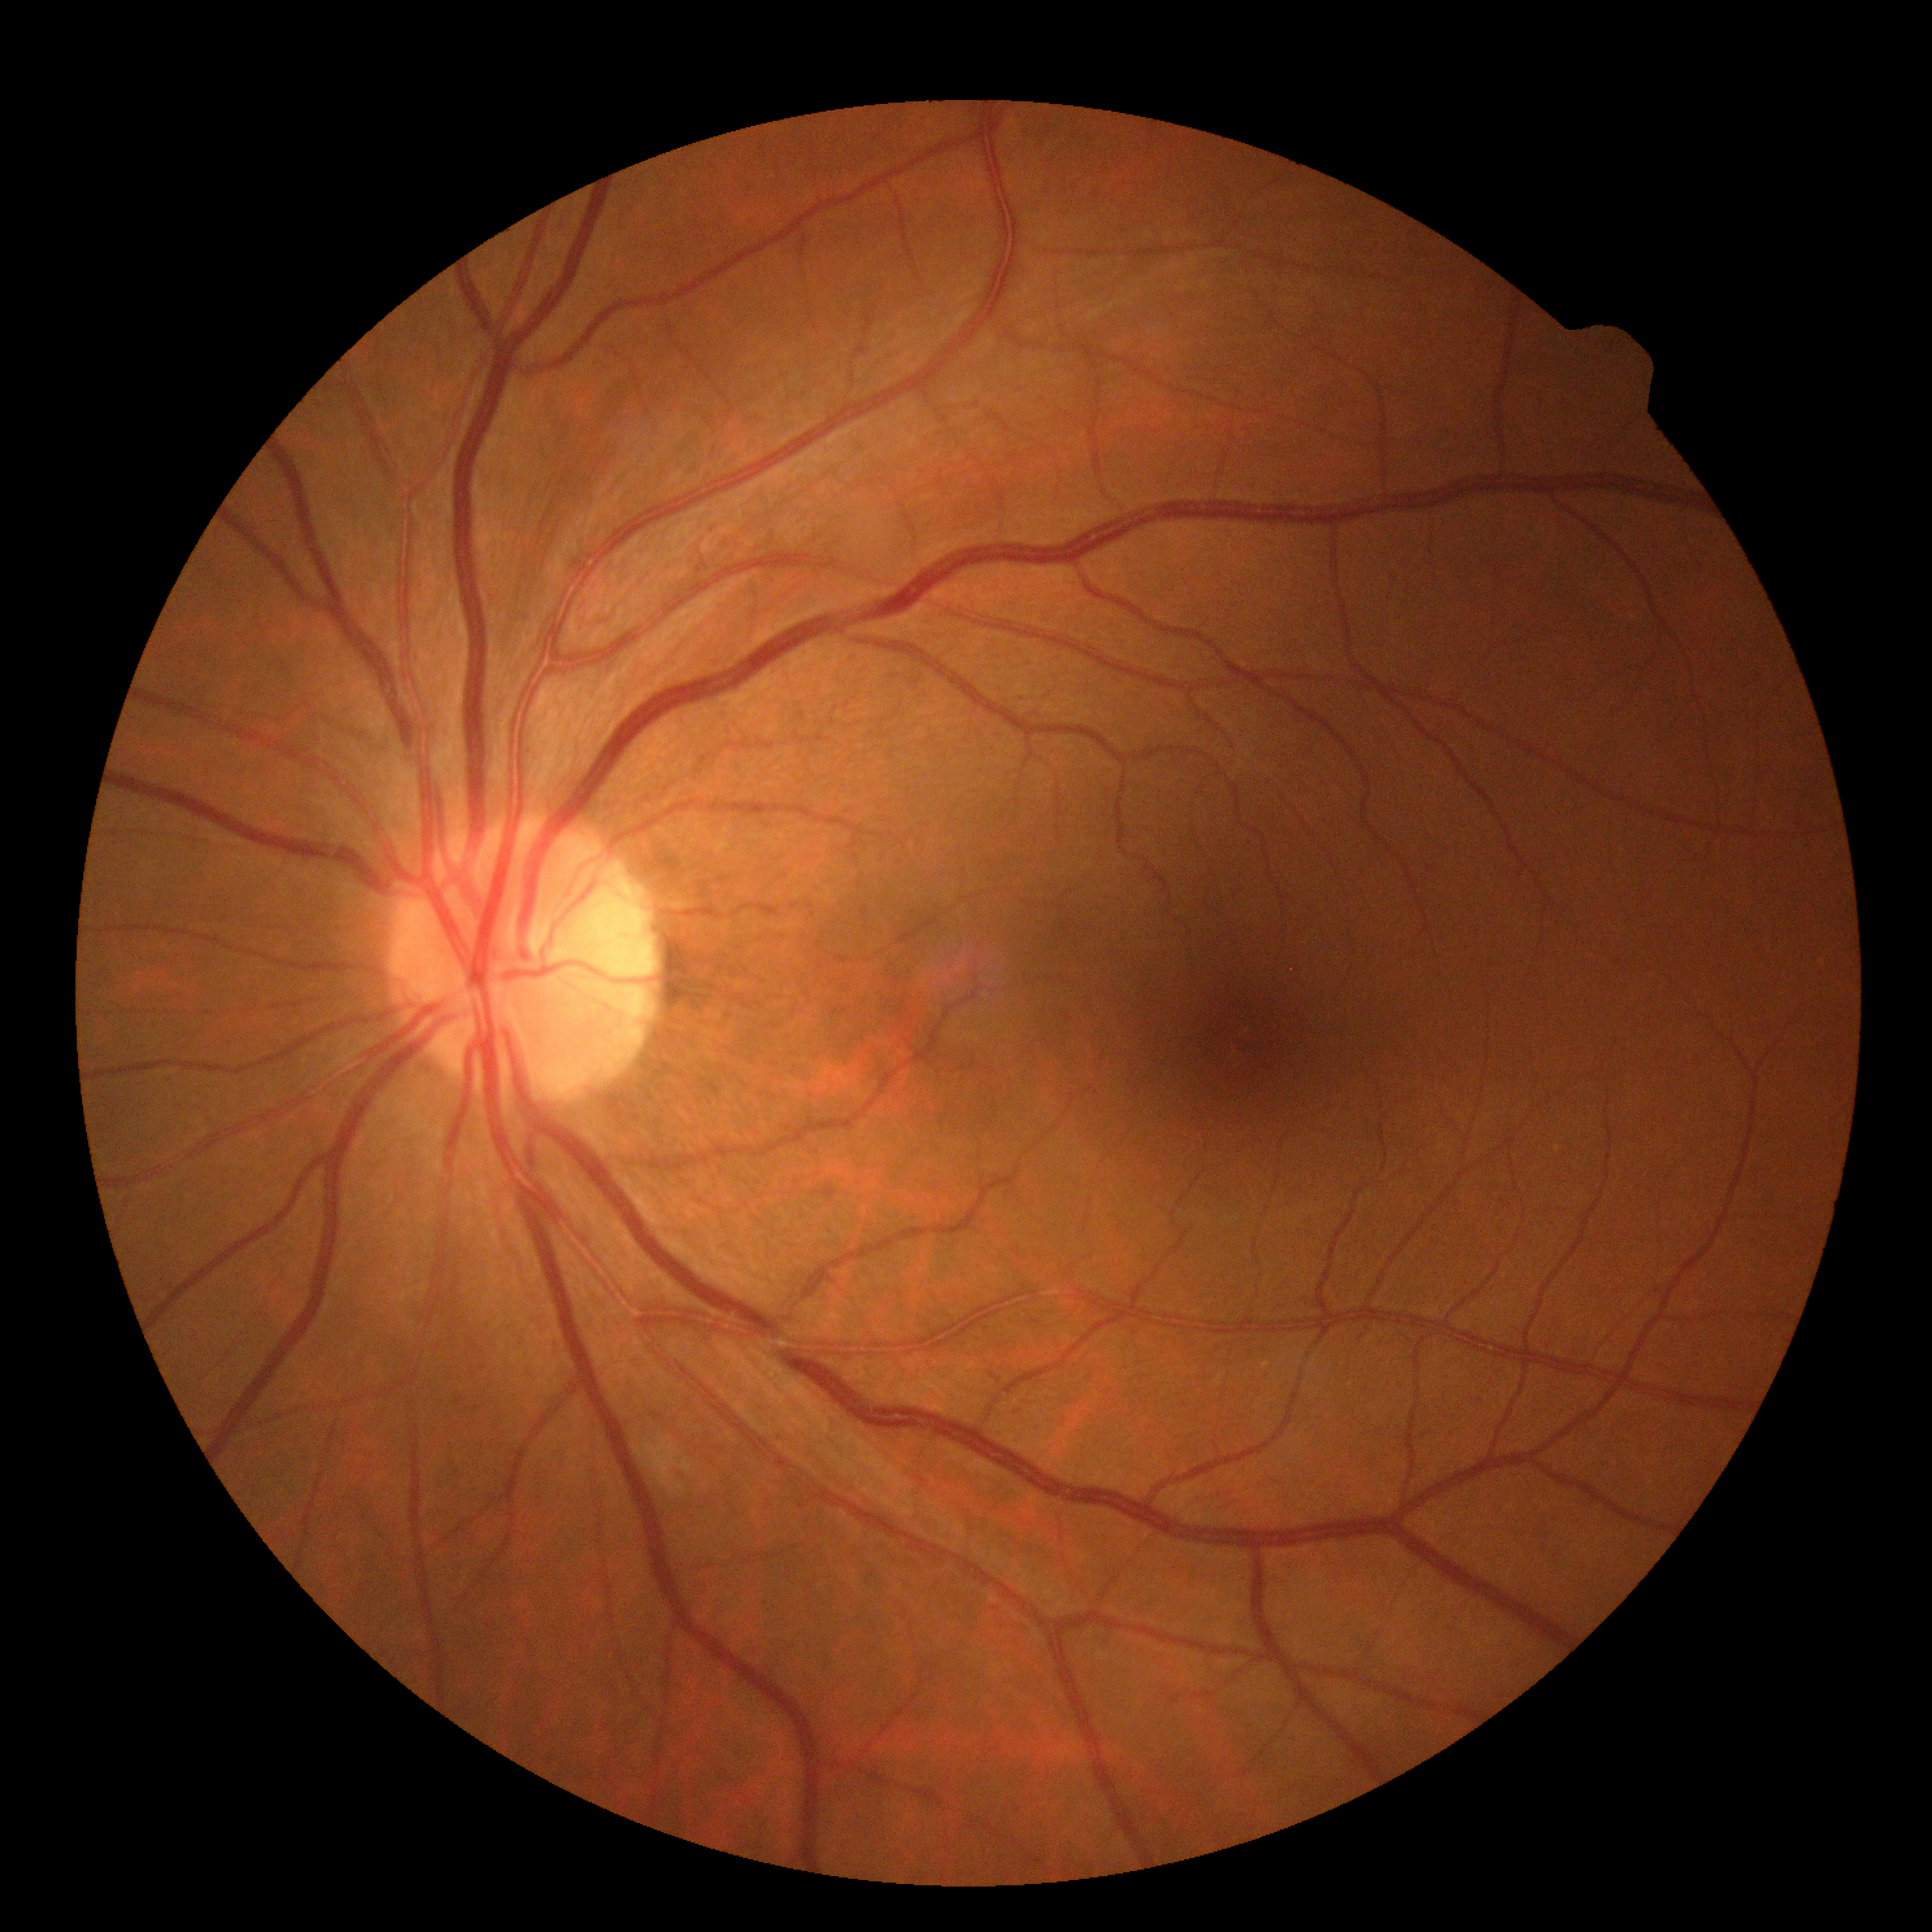

  dr_grade: 0